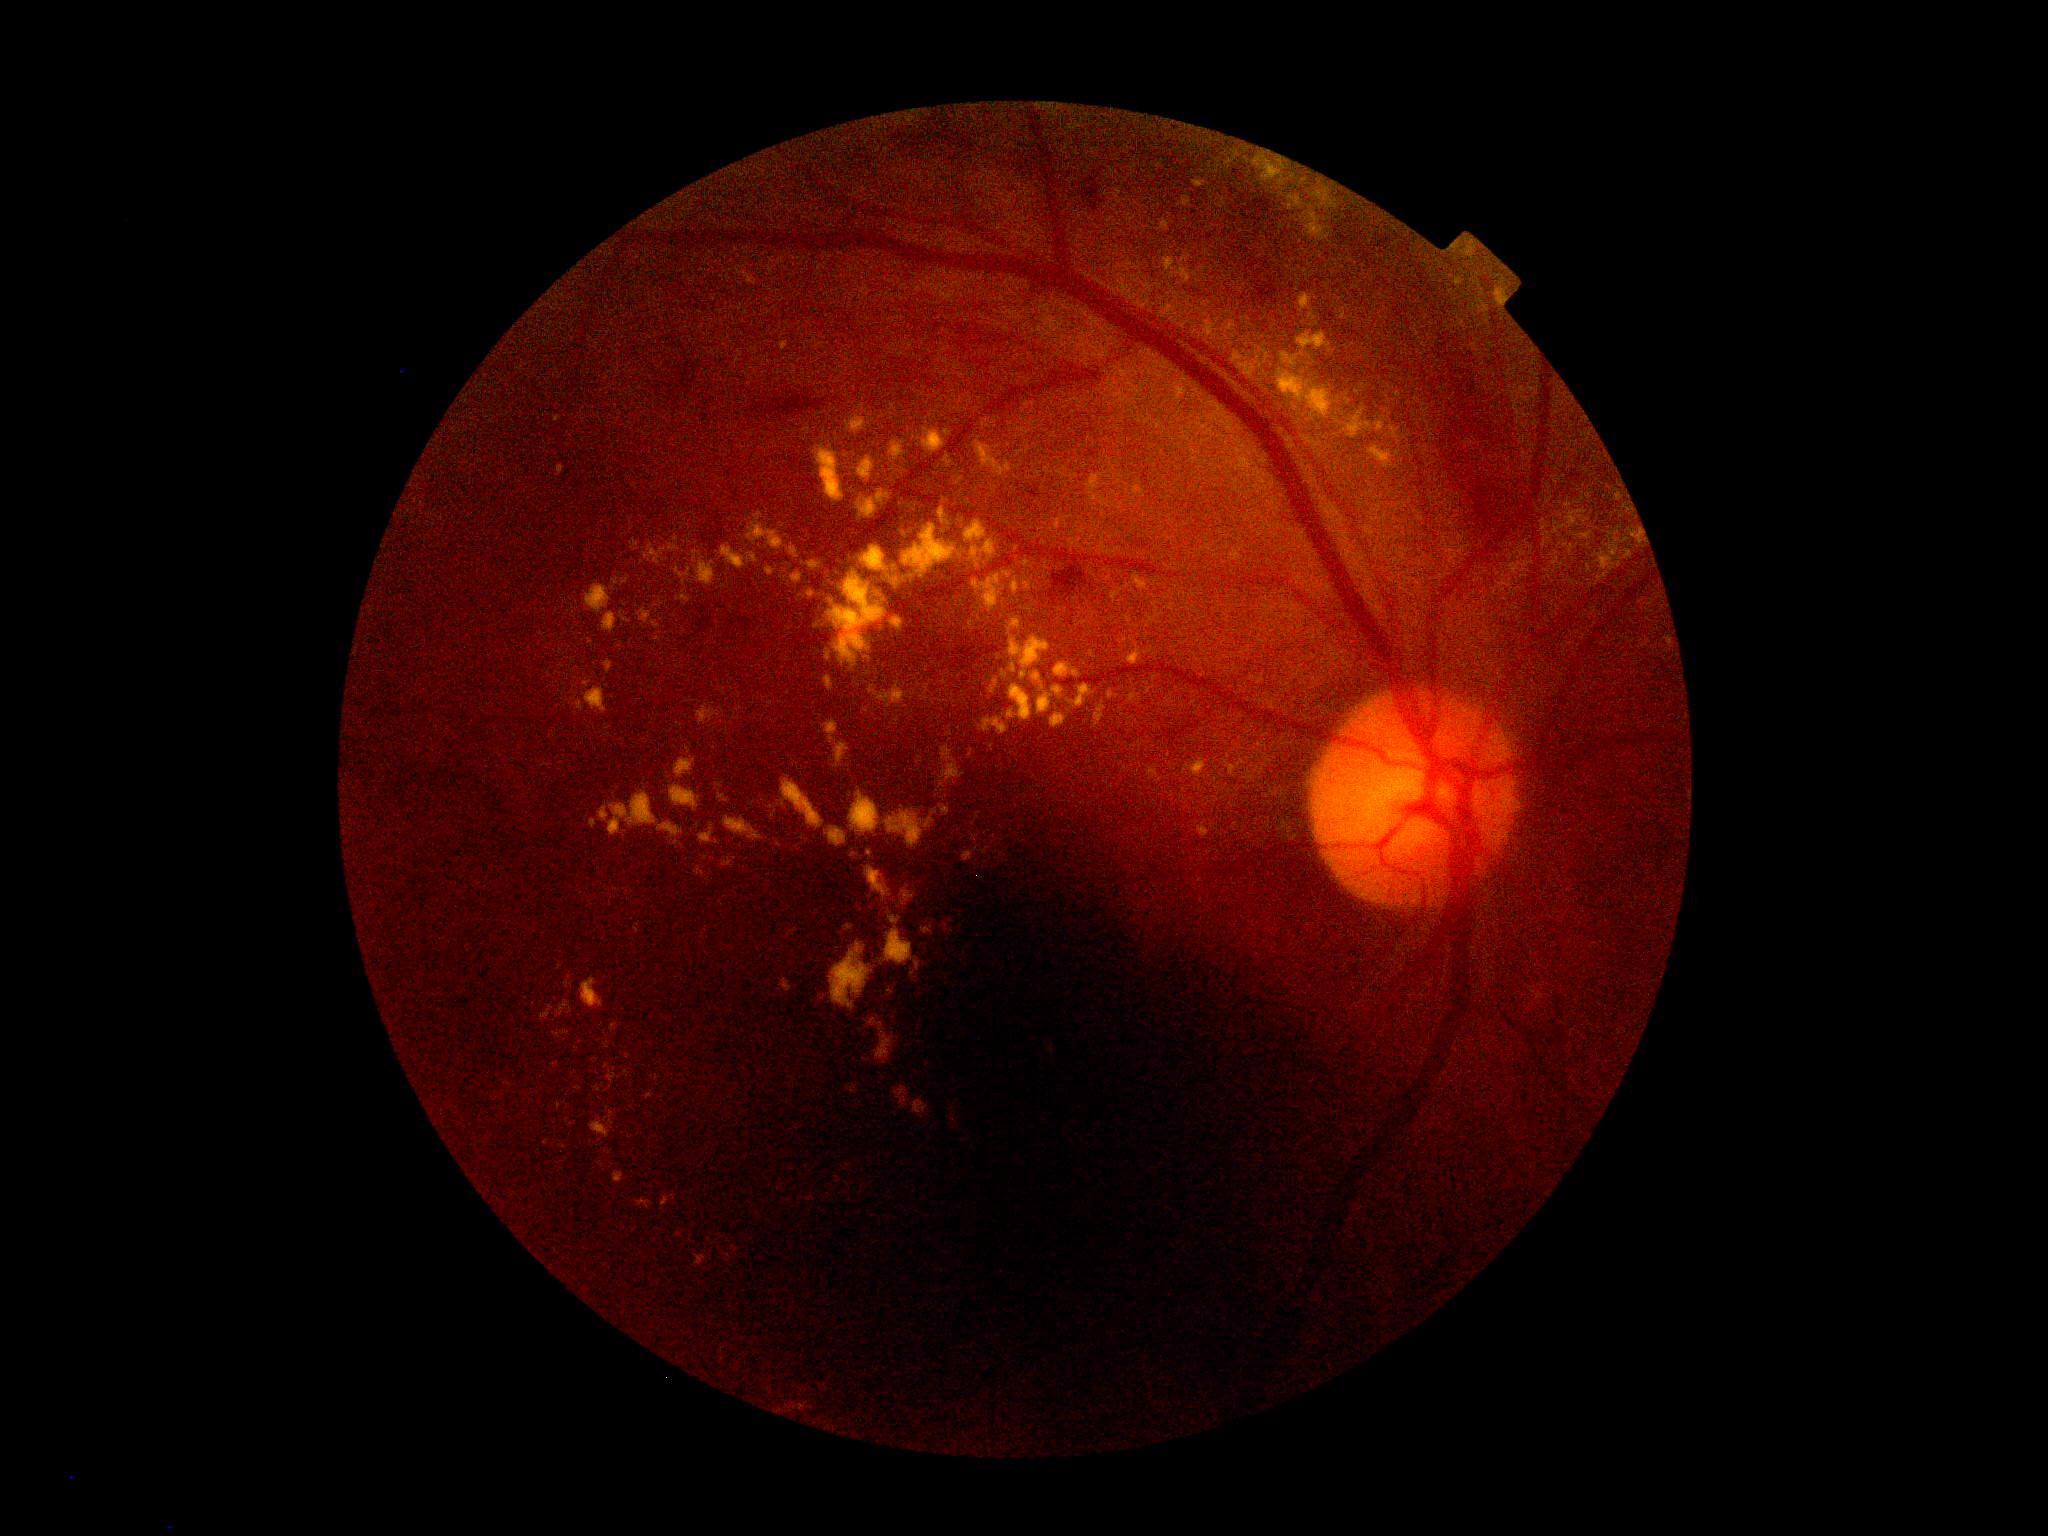
Retinopathy is 2. Disease class: non-proliferative diabetic retinopathy.